FOV: 45 degrees · 2352 x 1568 pixels
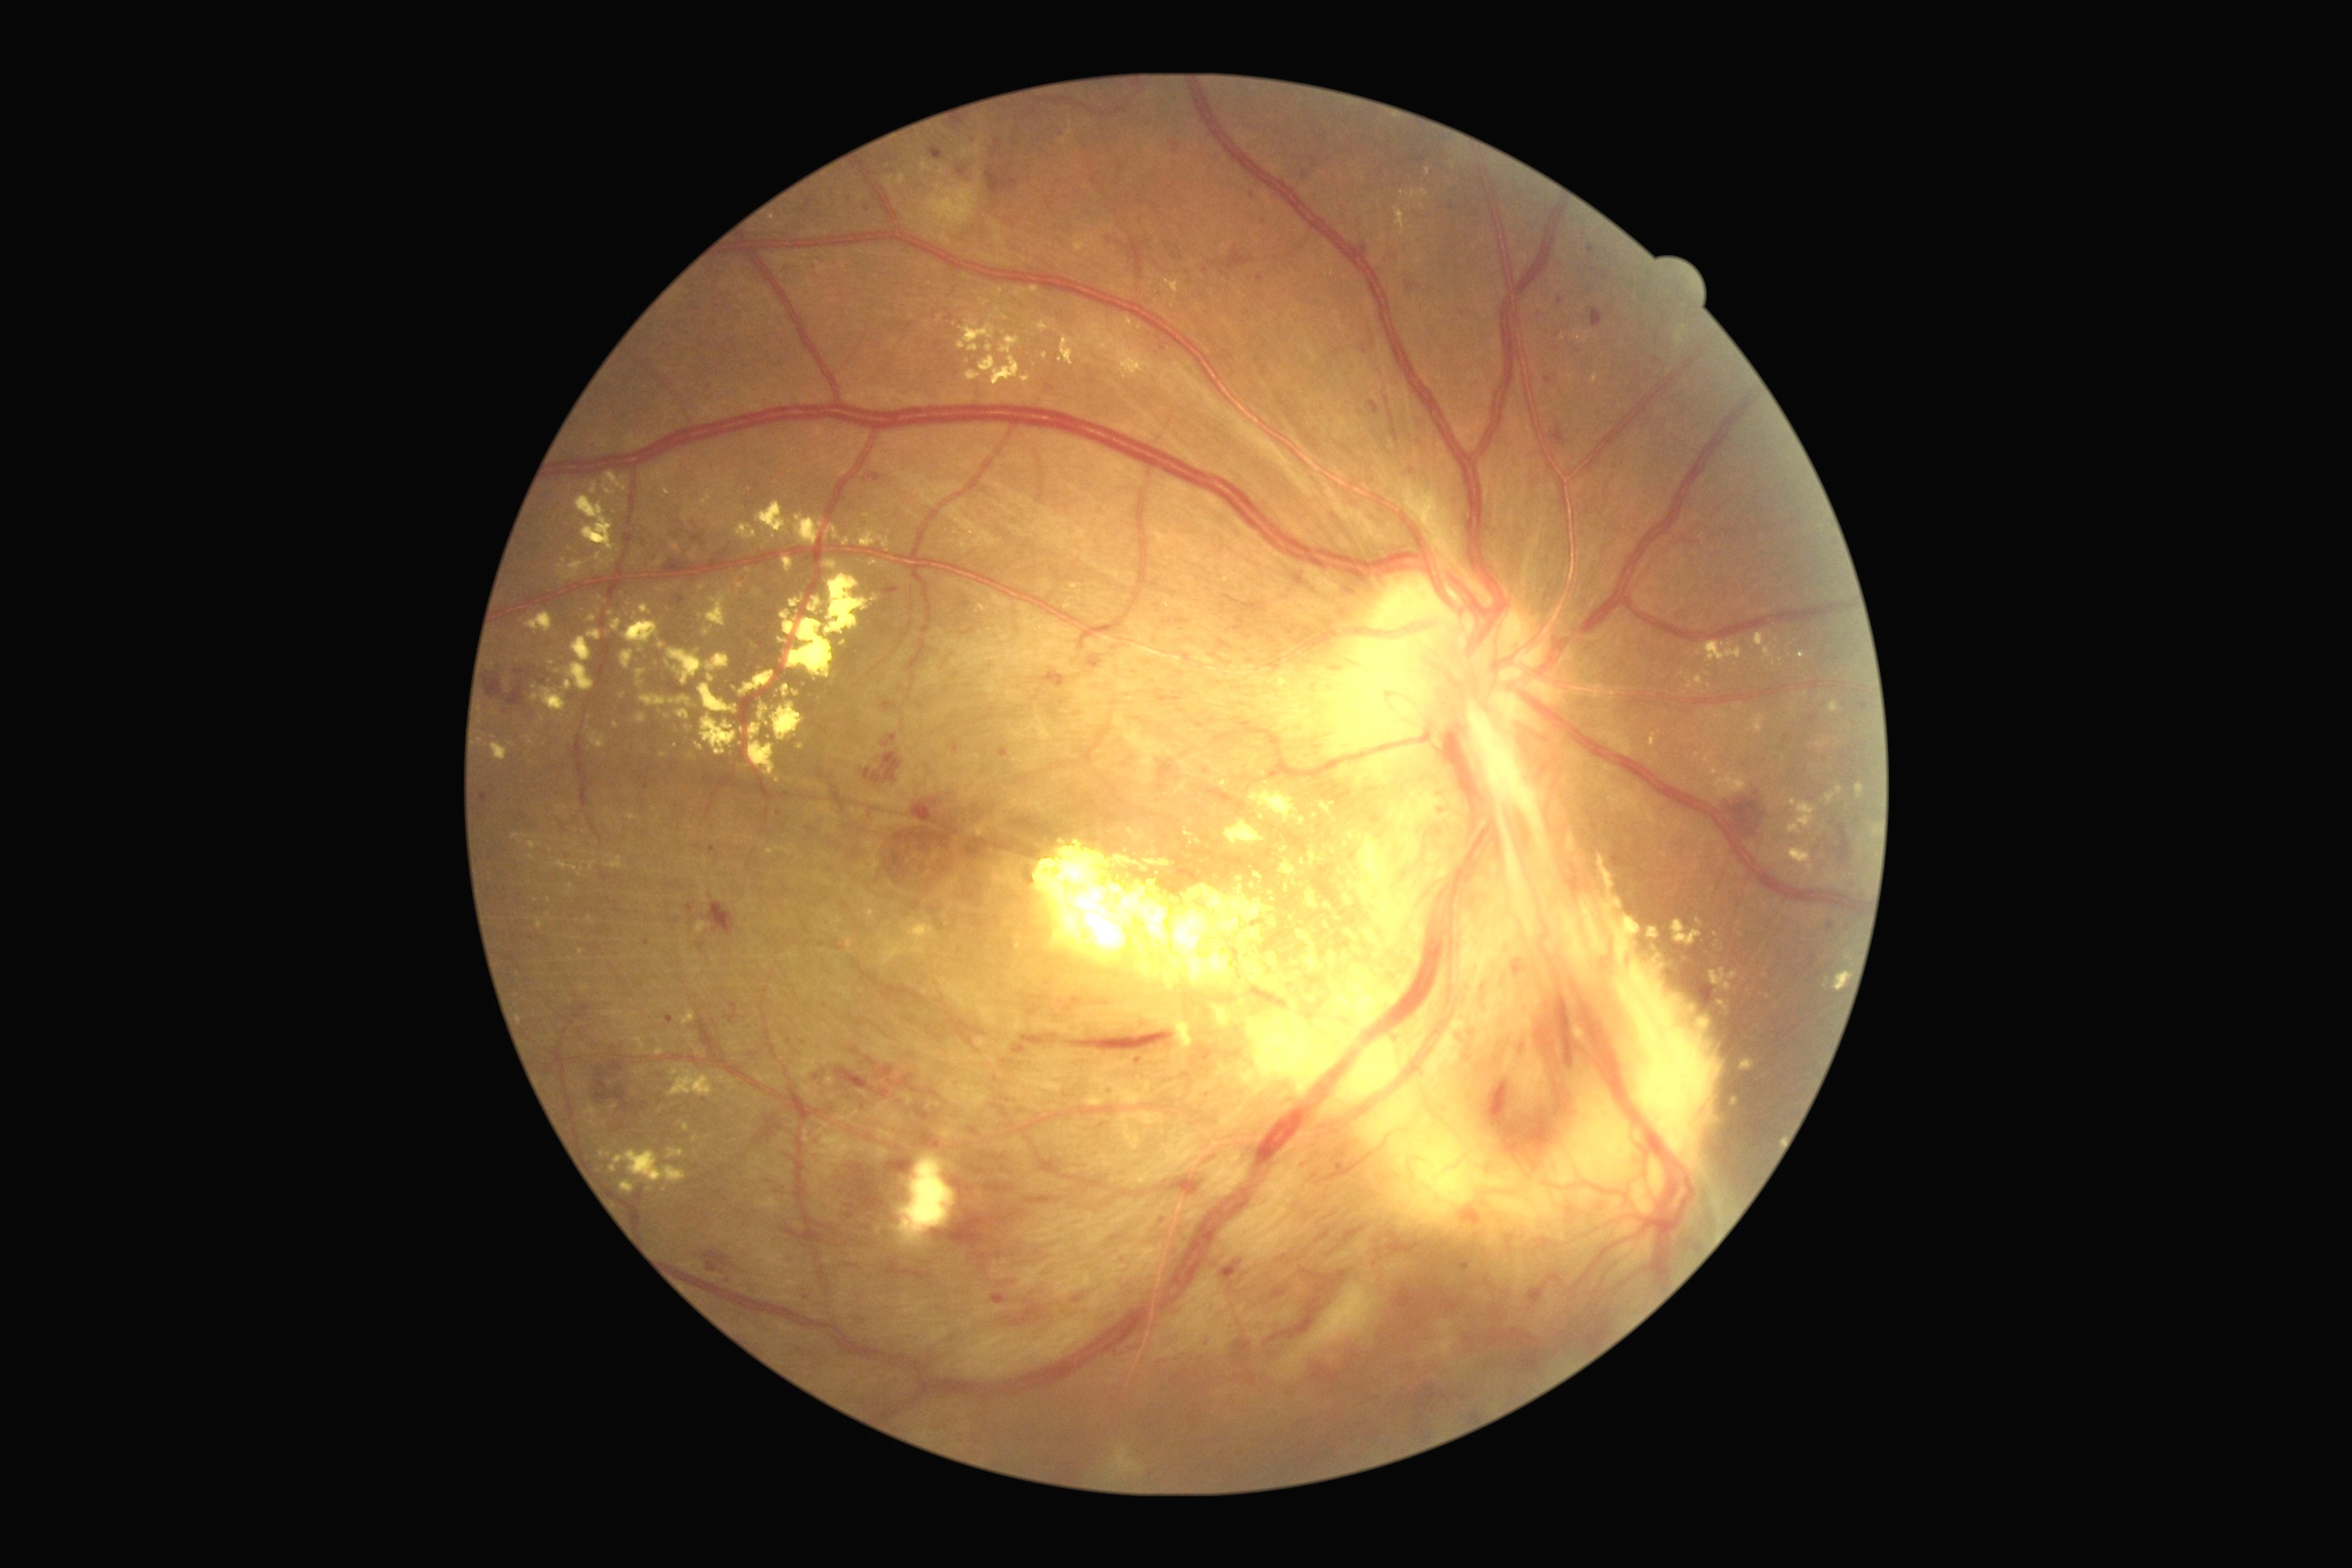 Diabetic retinopathy (DR) is grade 4
Representative lesions:
hard exudates (EXs) (continued): bbox(790, 593, 808, 609) | bbox(700, 685, 738, 714) | bbox(1064, 603, 1073, 609) | bbox(660, 643, 667, 651) | bbox(564, 629, 602, 692) | bbox(838, 640, 848, 647) | bbox(1828, 701, 1839, 712) | bbox(1059, 335, 1081, 366) | bbox(671, 696, 691, 707) | bbox(783, 685, 790, 698) | bbox(636, 669, 645, 687) | bbox(583, 1102, 598, 1128) | bbox(730, 687, 738, 692) | bbox(603, 485, 616, 496)
Smaller EXs around (1070, 132) | (1335, 852) | (623, 480) | (611, 614) | (531, 858)